Natus RetCam Envision, 130° FOV; RetCam wide-field infant fundus image.
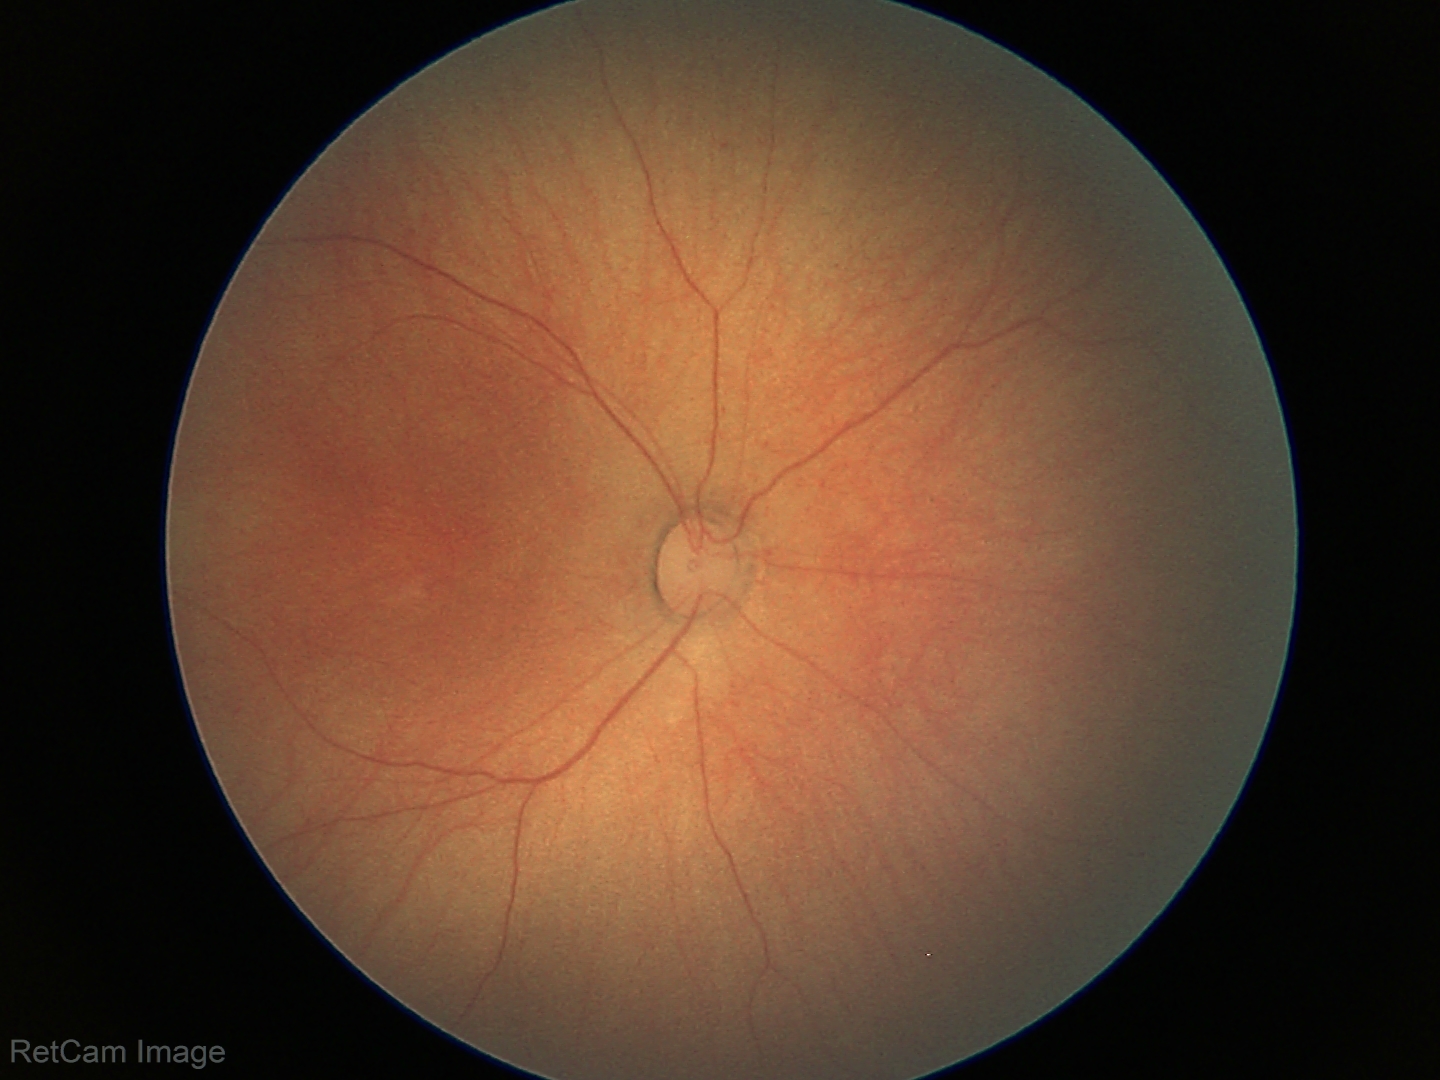
Physiological retinal appearance for postconceptual age.